Acquired with a NIDEK AFC-230 — 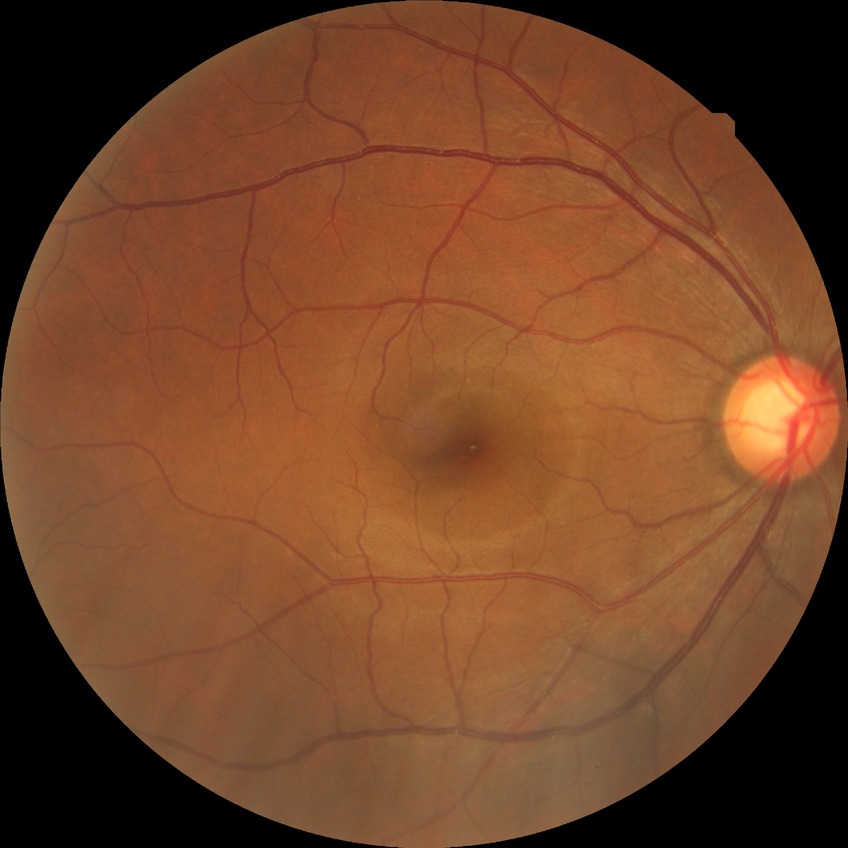

DR impression = no apparent DR; DR grade = NDR.